Modified Davis grading: 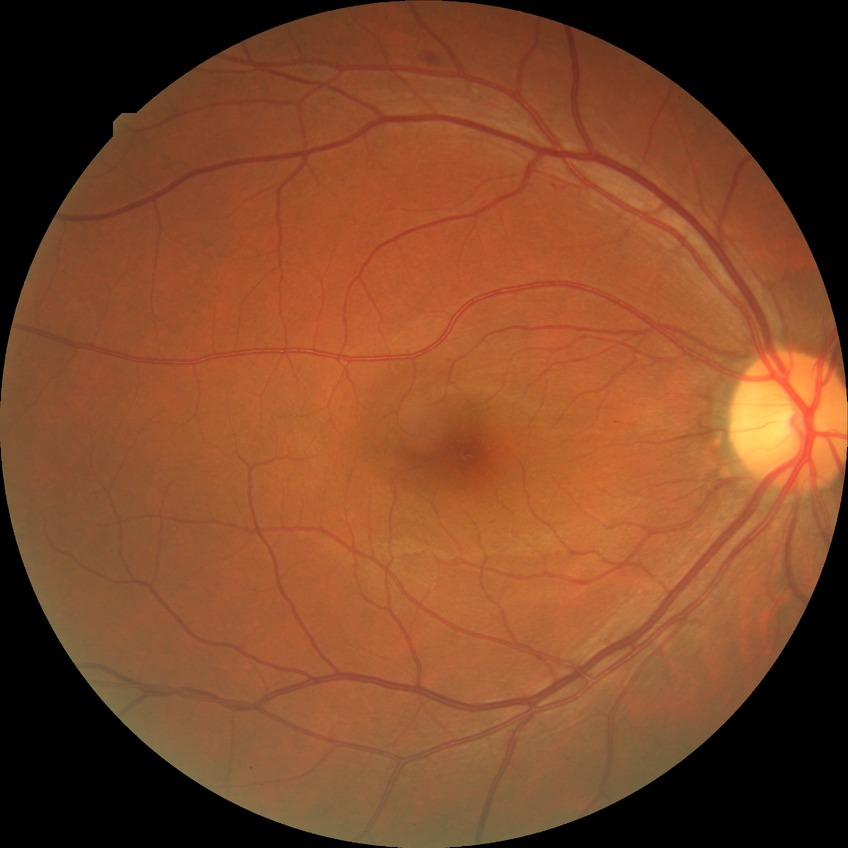

Modified Davis classification is simple diabetic retinopathy. The retinopathy is classified as non-proliferative diabetic retinopathy.